Fundus photo. Acquired with a NIDEK AFC-230. 45° FOV — 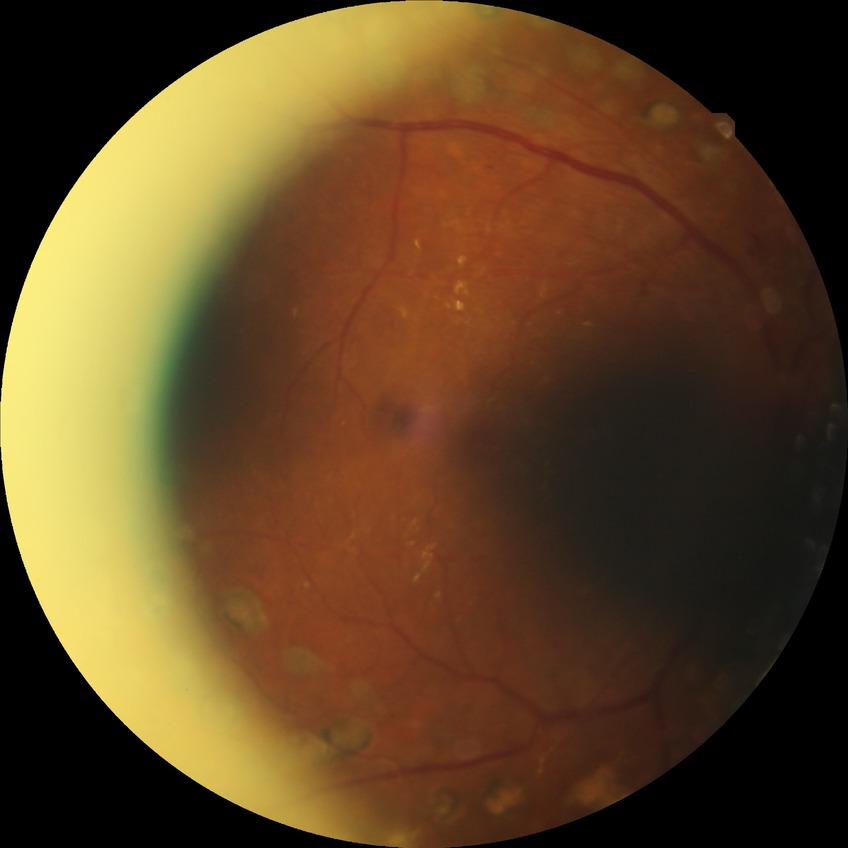
Findings:
- diabetic retinopathy stage — proliferative diabetic retinopathy